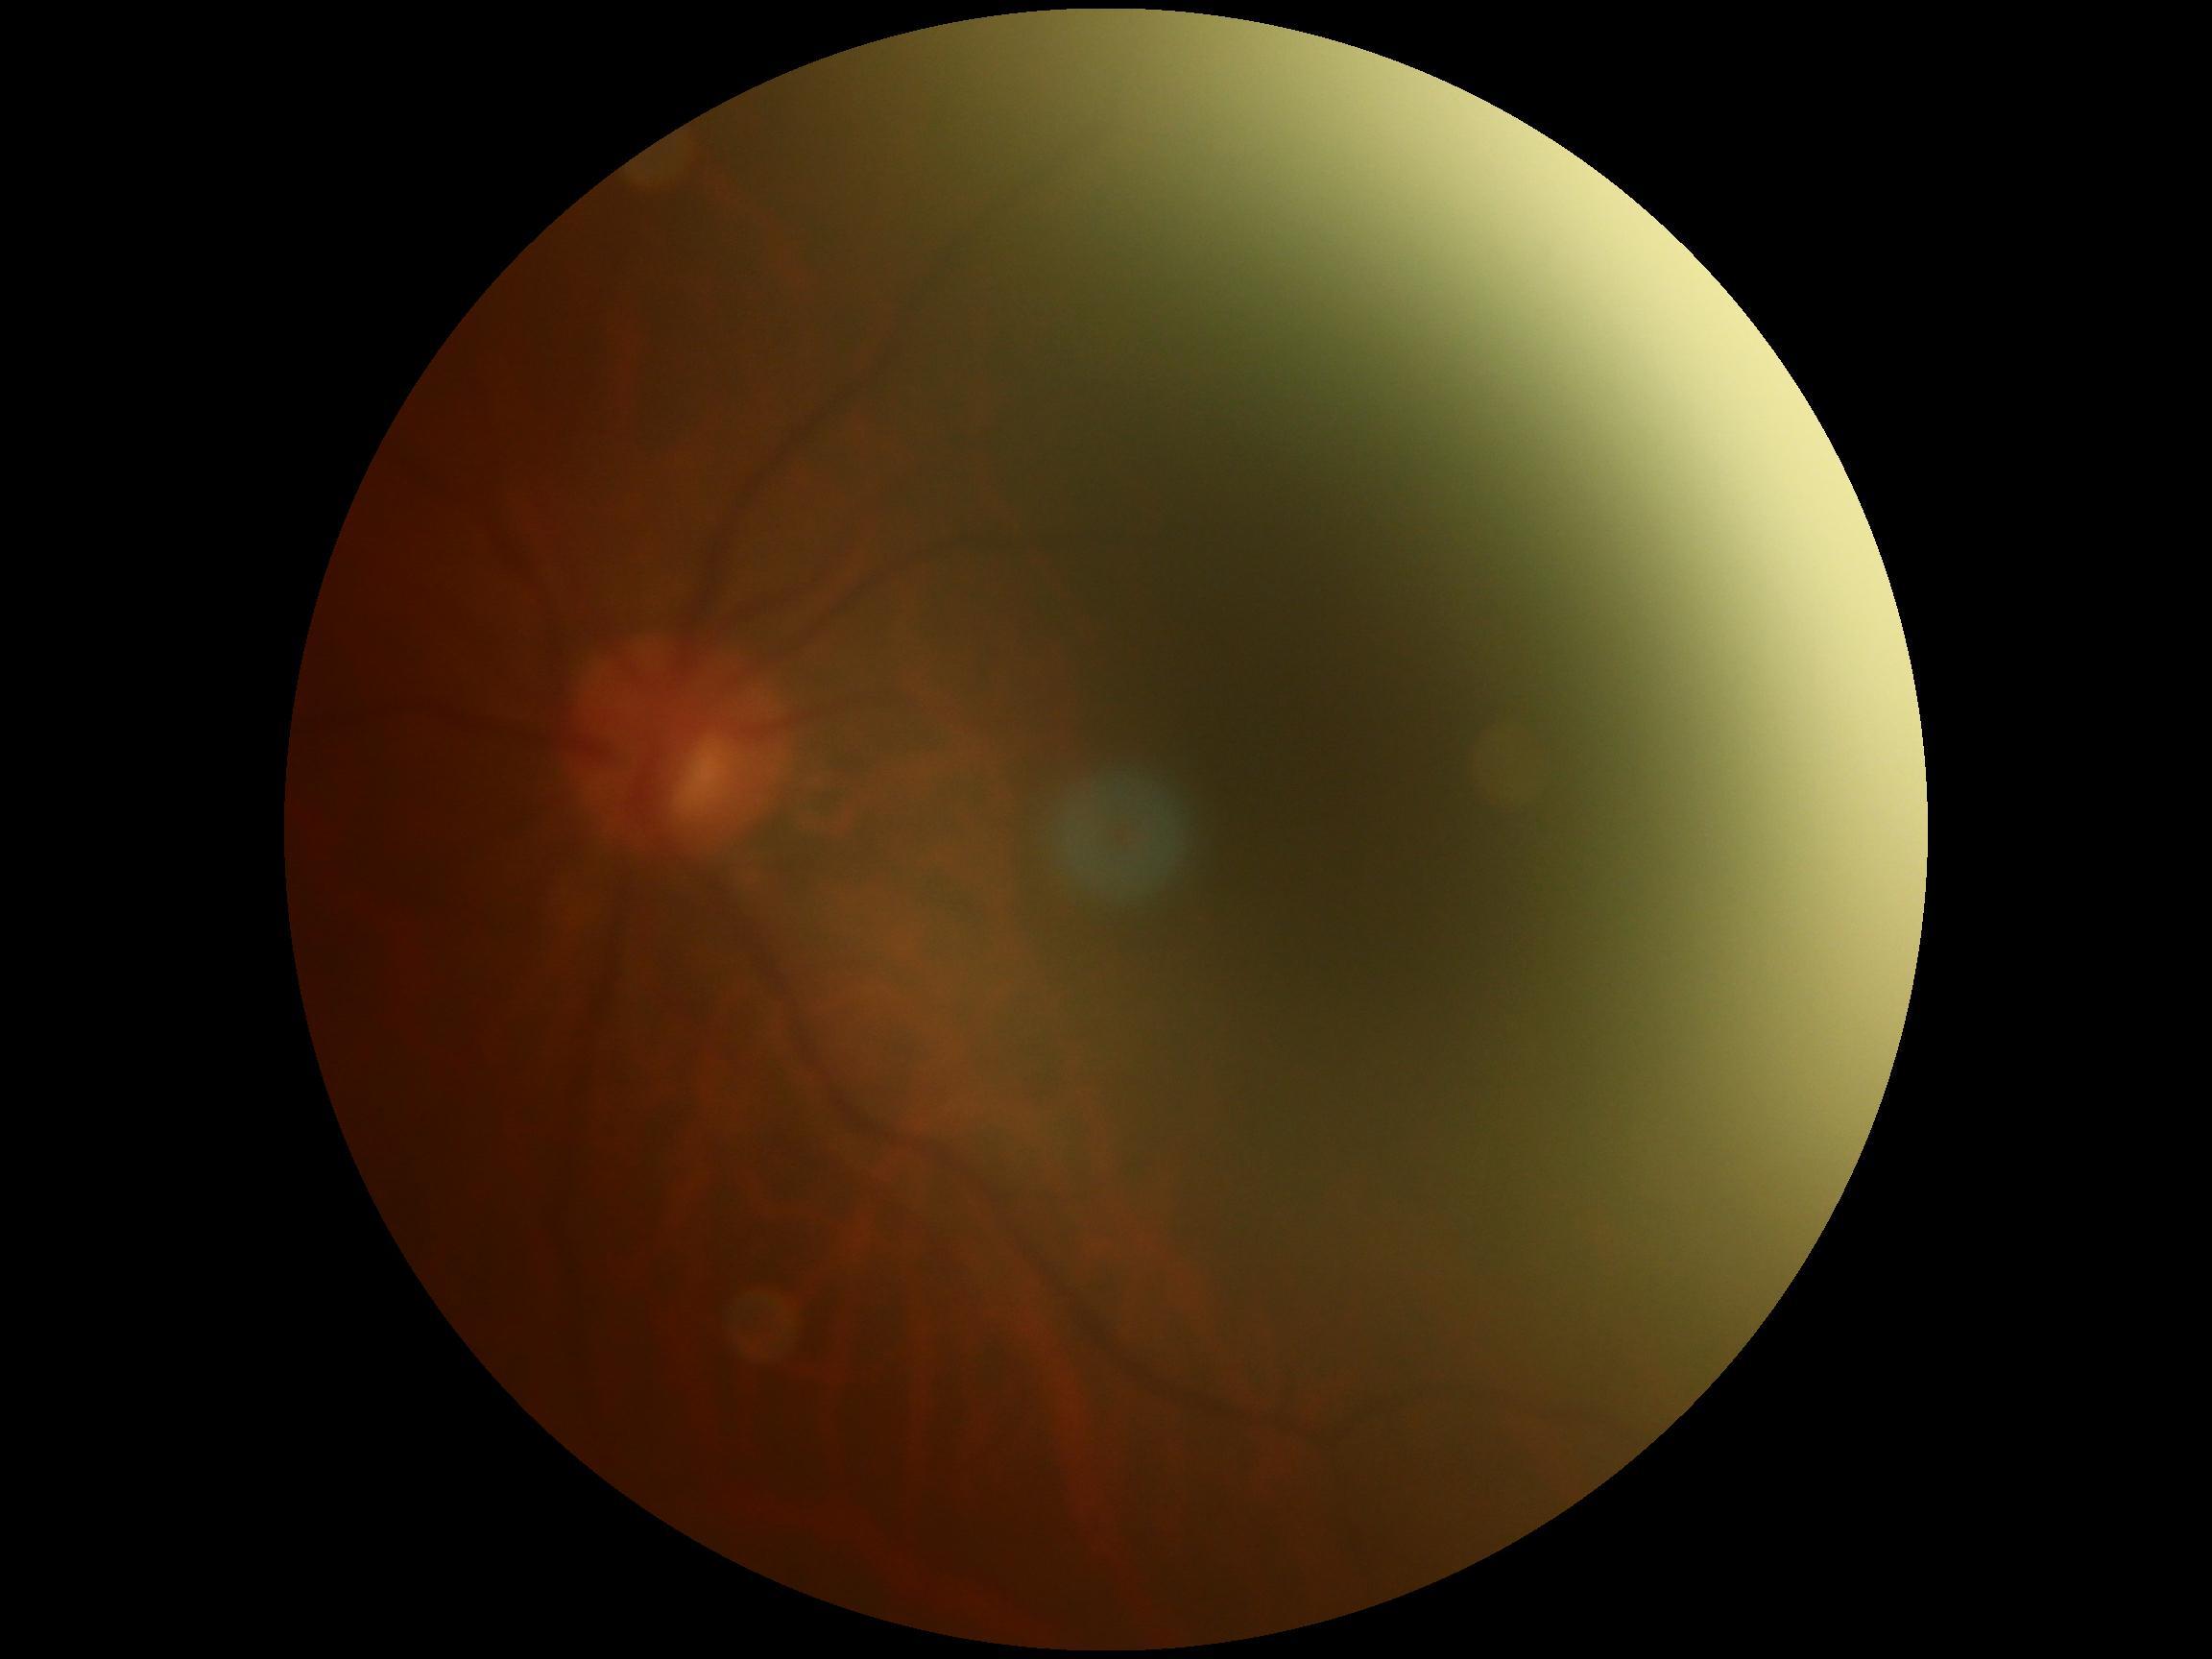

DR is ungradable.